NIDEK AFC-230. Modified Davis grading. 45-degree field of view. Nonmydriatic:
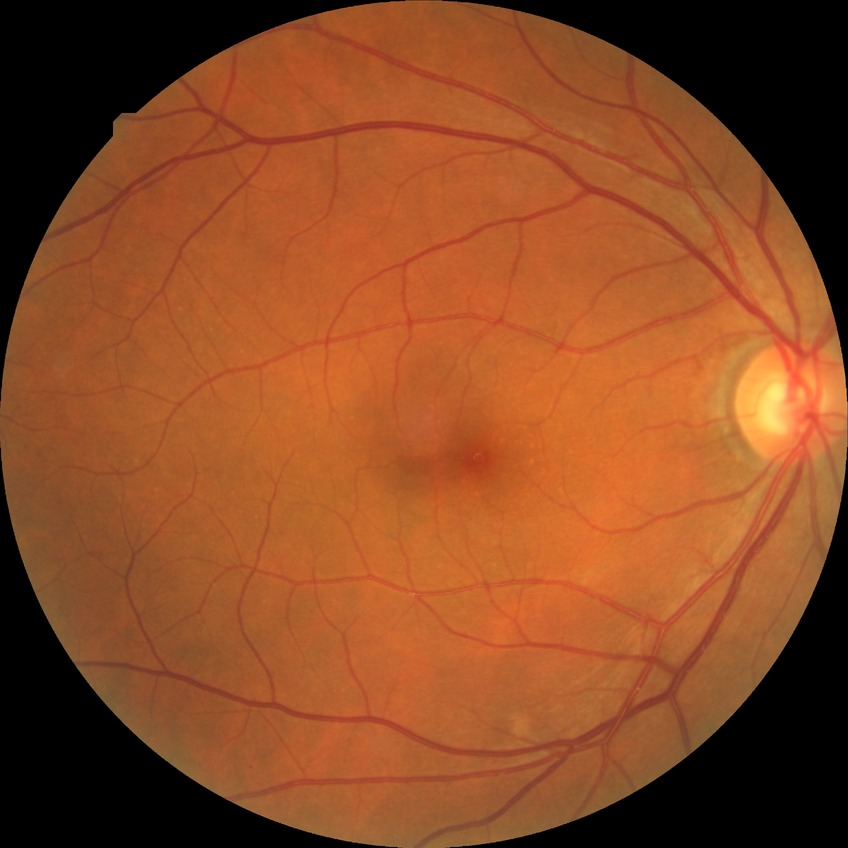
davis_grade: no diabetic retinopathy